Image size 240x240 · captured on a Nidek AFC-330 fundus camera
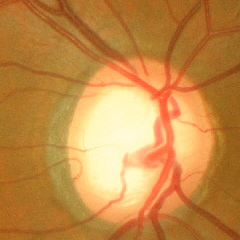
Optic disc photograph demonstrating early glaucomatous optic neuropathy.